640x480 · wide-field fundus photograph from neonatal ROP screening
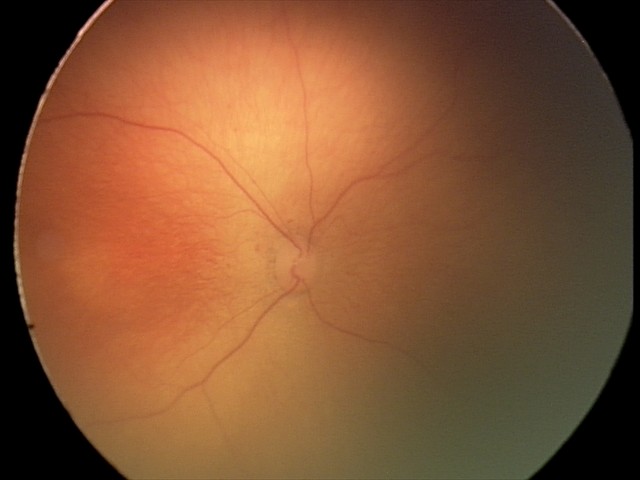 No plus disease. Series diagnosed as ROP stage 1.